Captured with the Clarity RetCam 3 (130° field of view); infant wide-field fundus photograph — 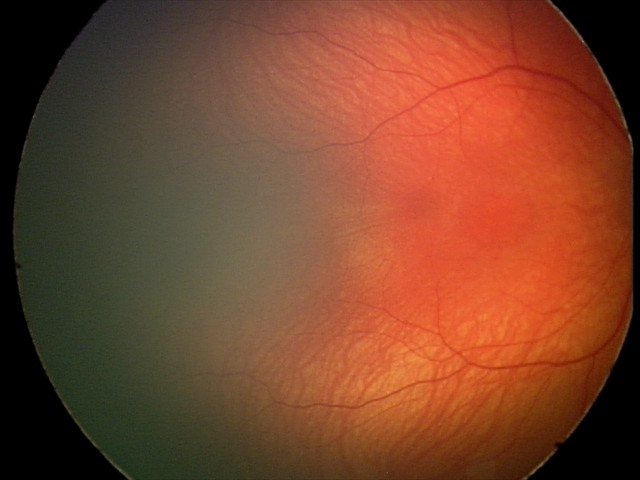
Screening examination diagnosed as physiological.